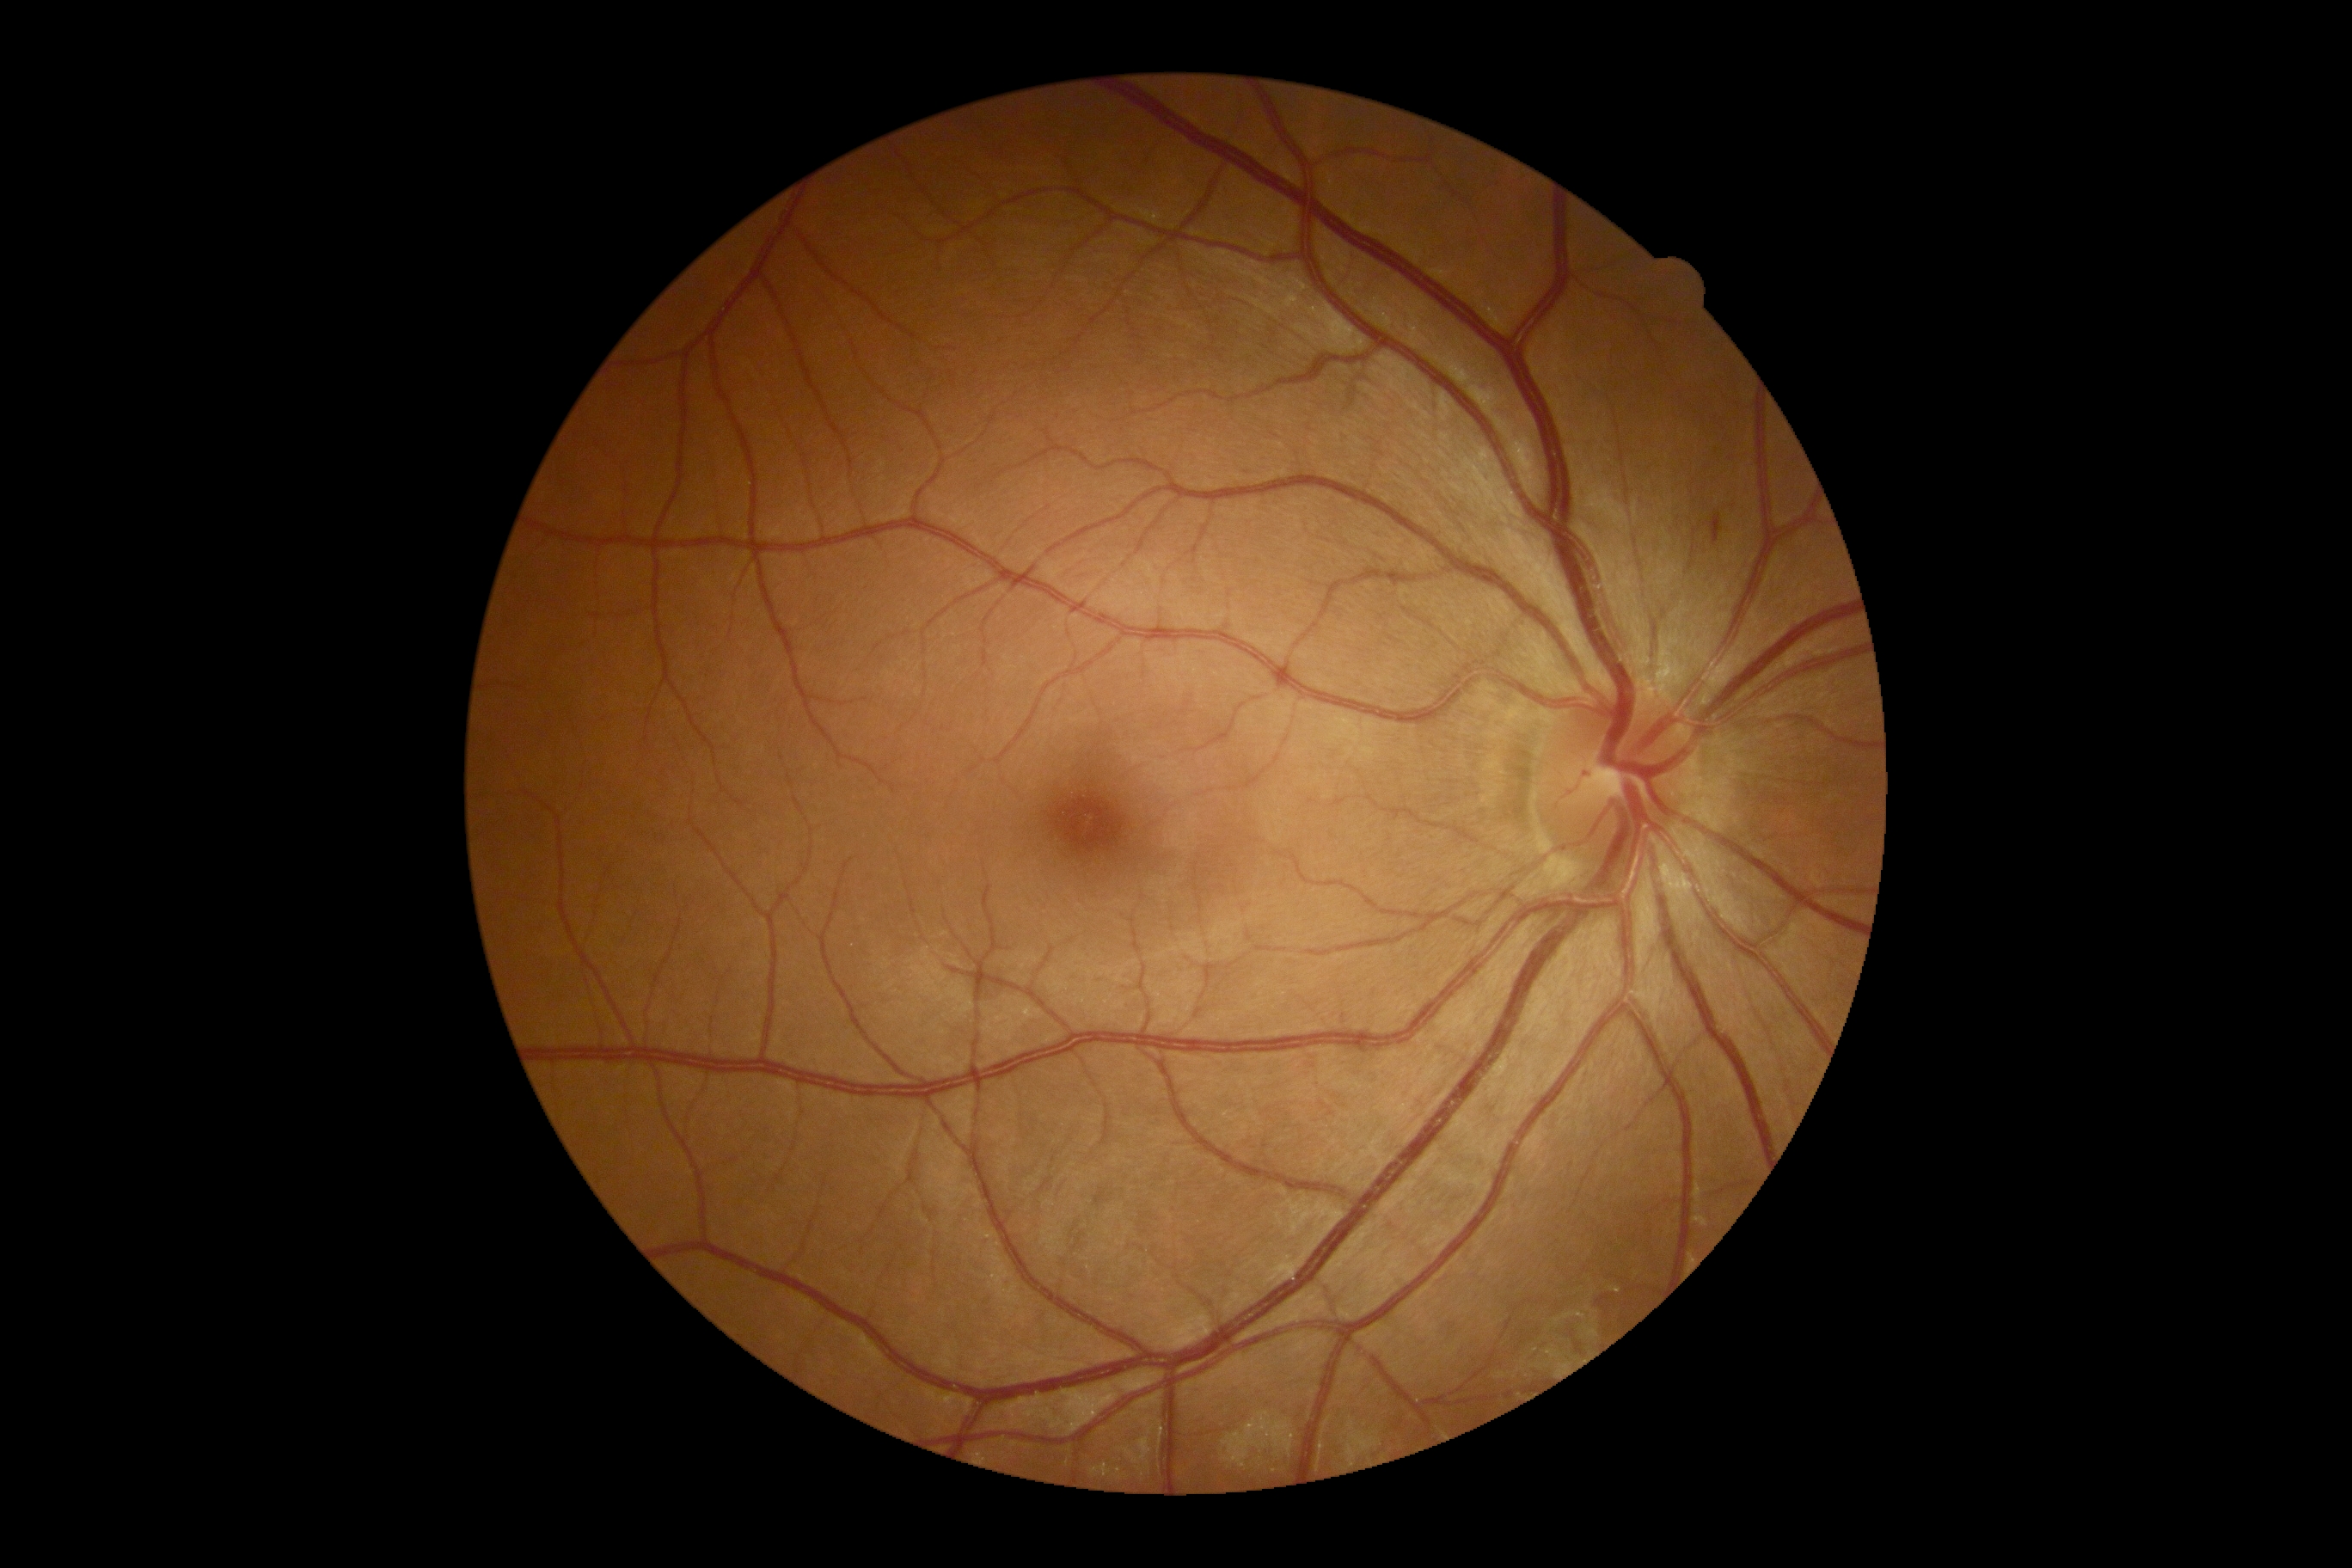 DR stage is moderate non-proliferative diabetic retinopathy (grade 2).